Wide-field fundus photograph of an infant.
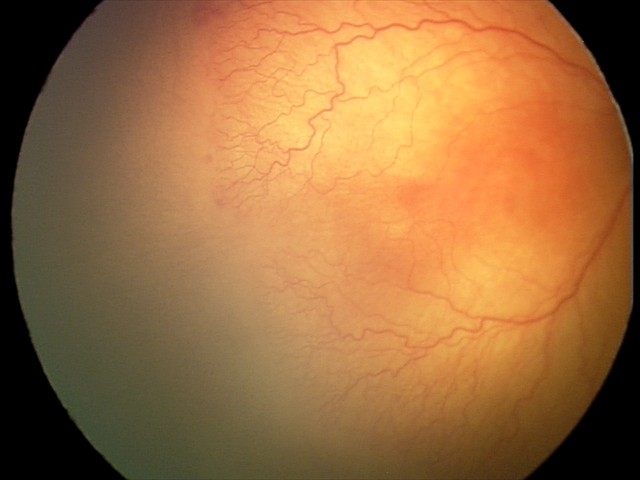
Plus disease present.
Screening examination consistent with aggressive retinopathy of prematurity.